Camera: Clarity RetCam 3 (130° FOV). Infant wide-field retinal image
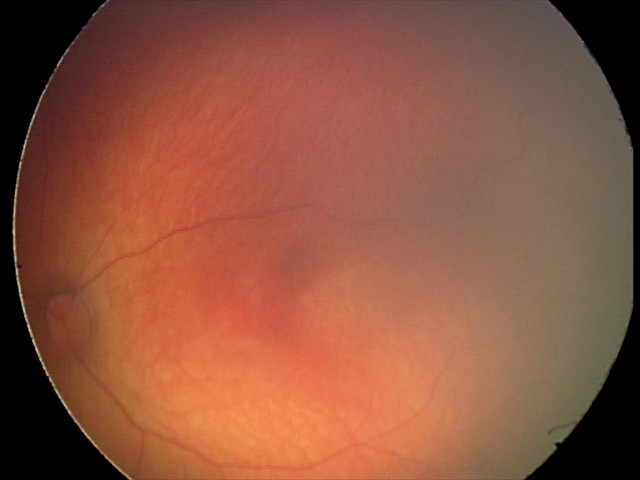

Physiological retinal appearance for postconceptual age.